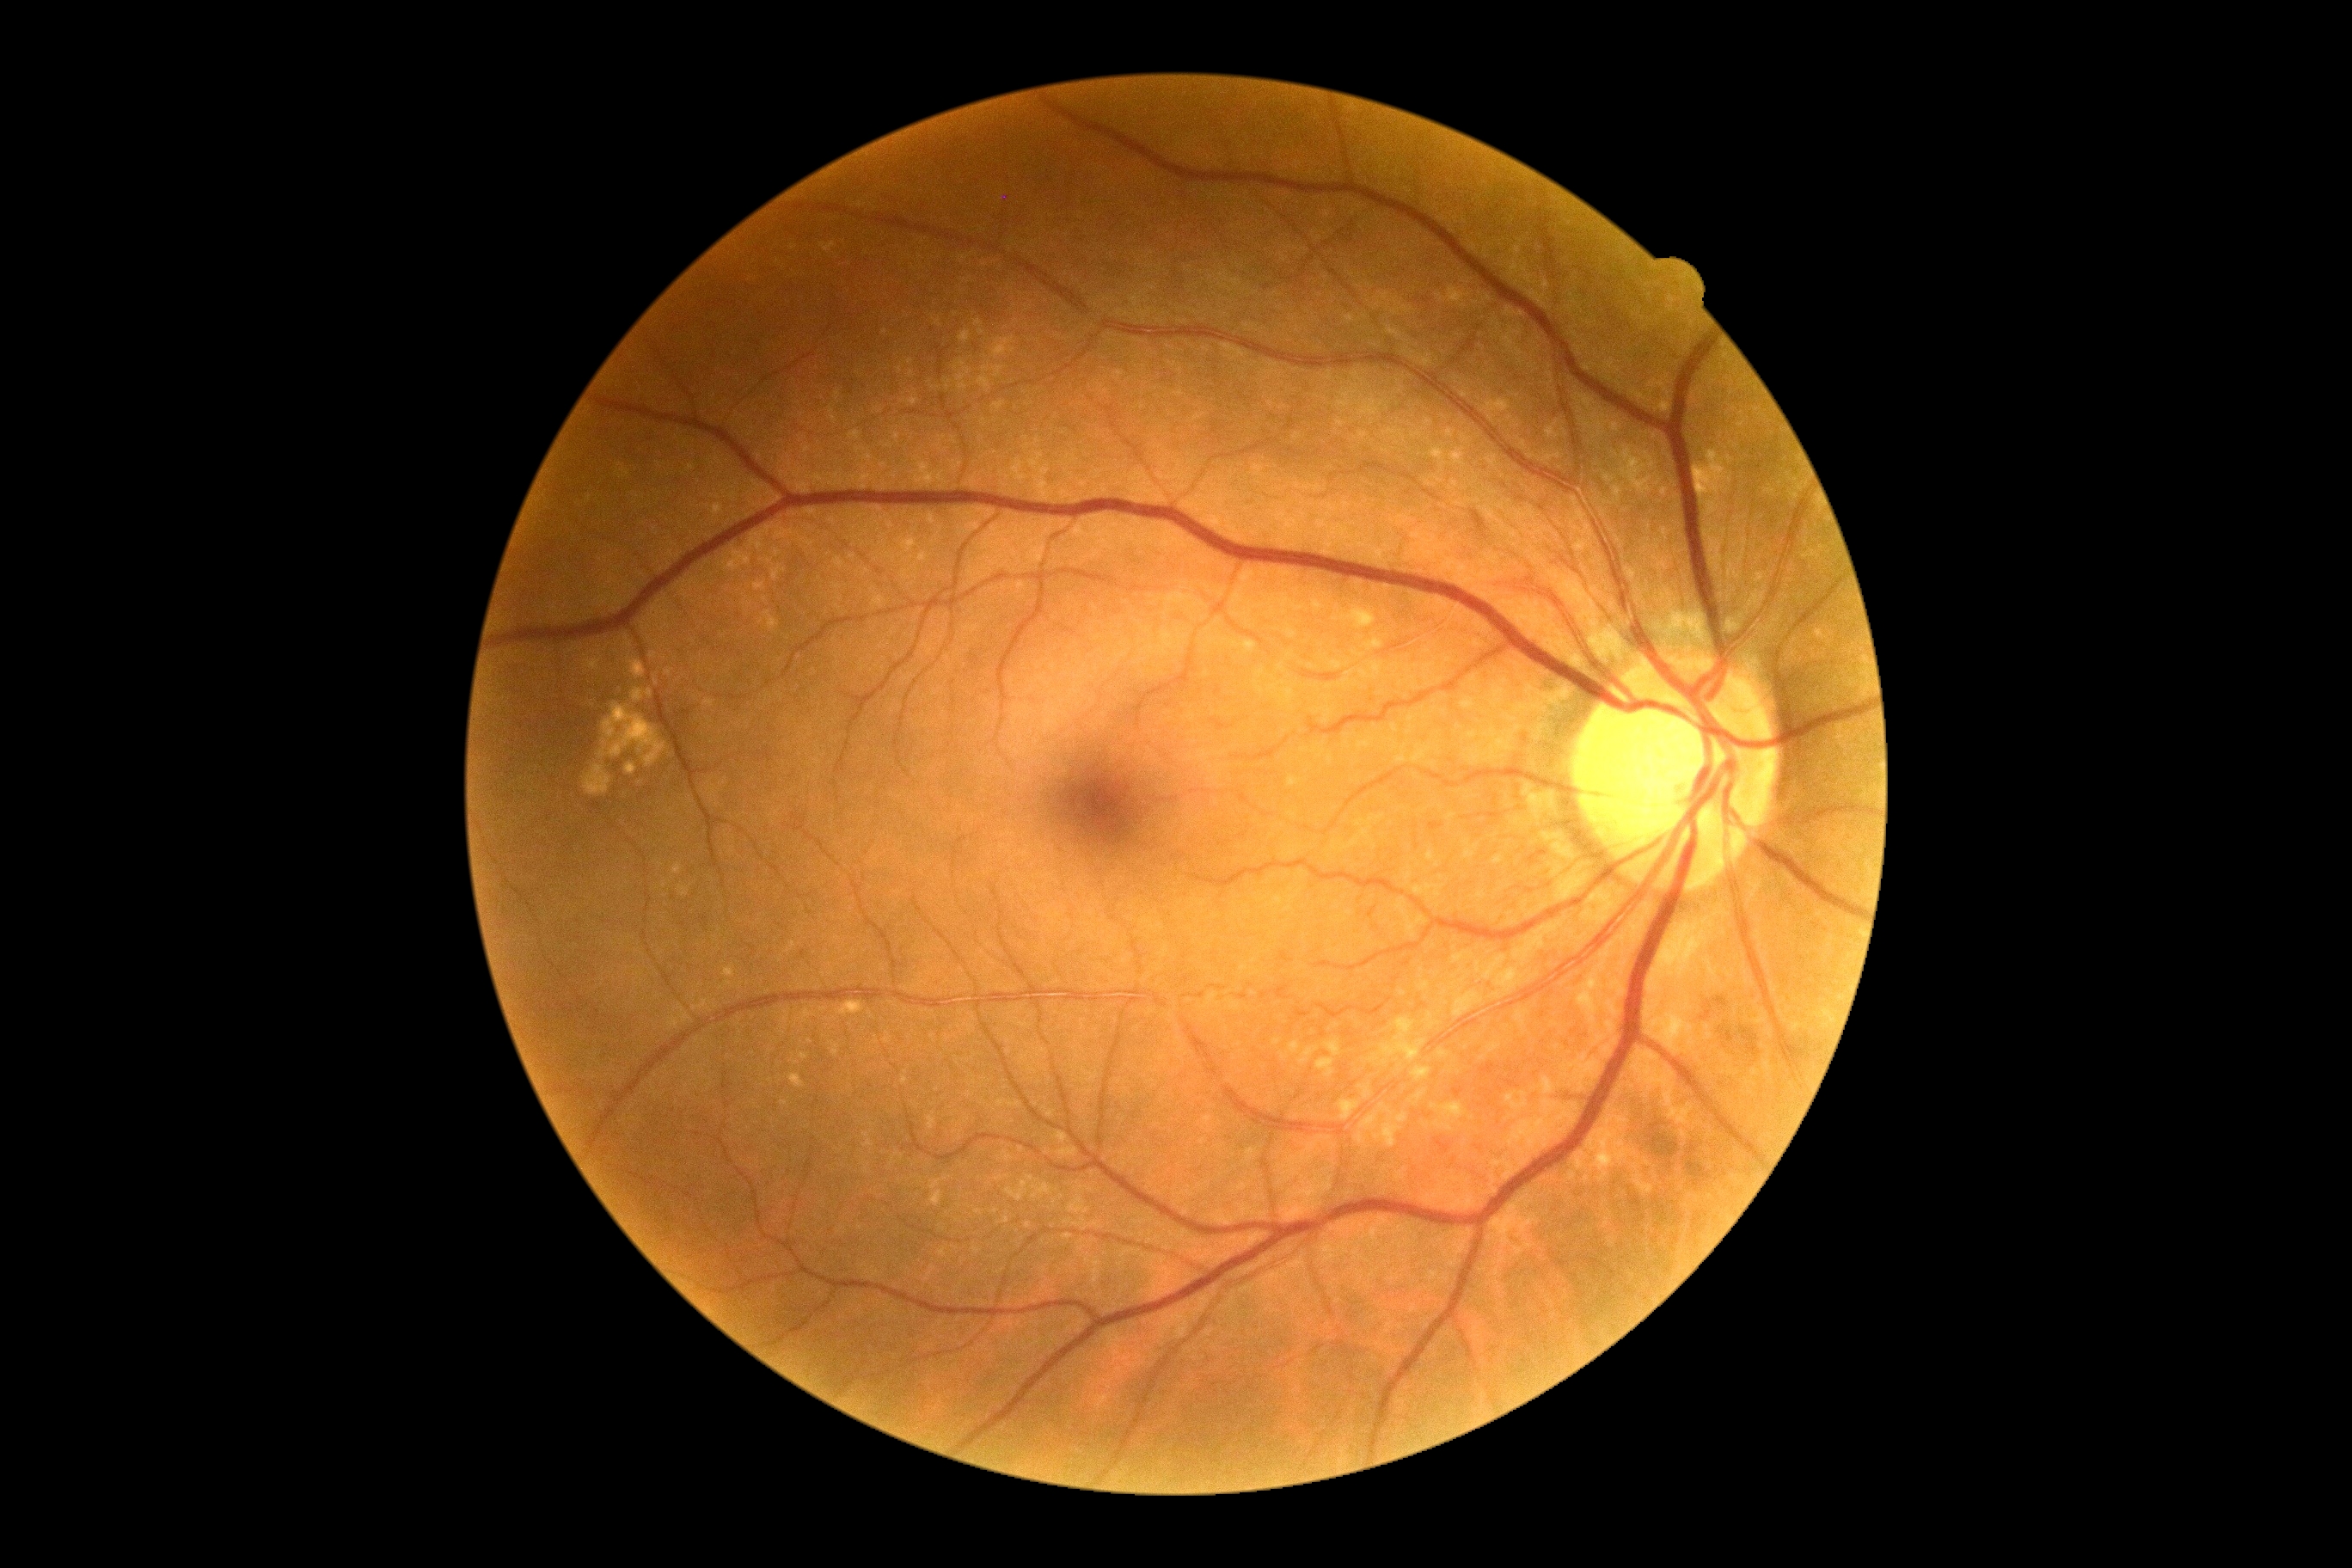

diabetic retinopathy severity = no apparent diabetic retinopathy (grade 0).